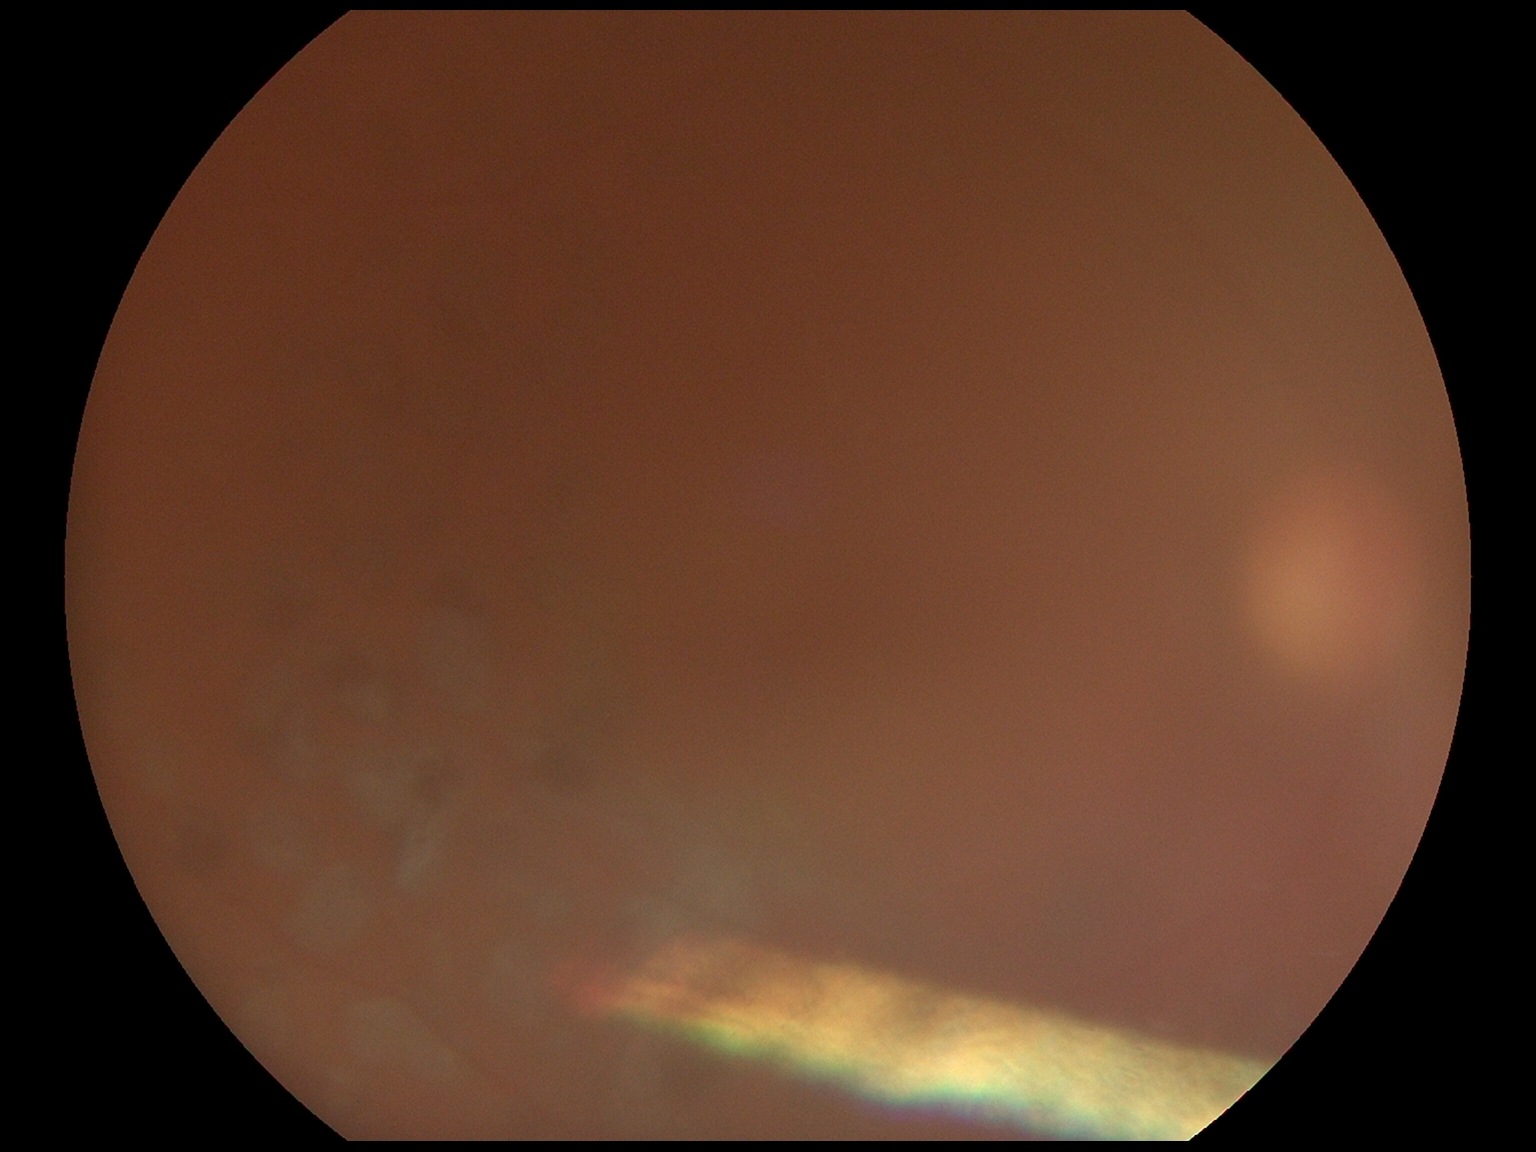

Annotations:
– DR grade — ungradable due to poor image quality